Color fundus photograph:
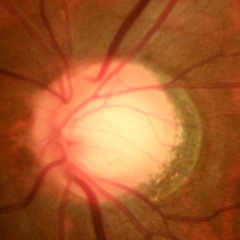 Q: Does this eye have glaucoma?
A: Yes — early glaucoma.